Captured with the Clarity RetCam 3 (130° field of view); pediatric wide-field fundus photograph — 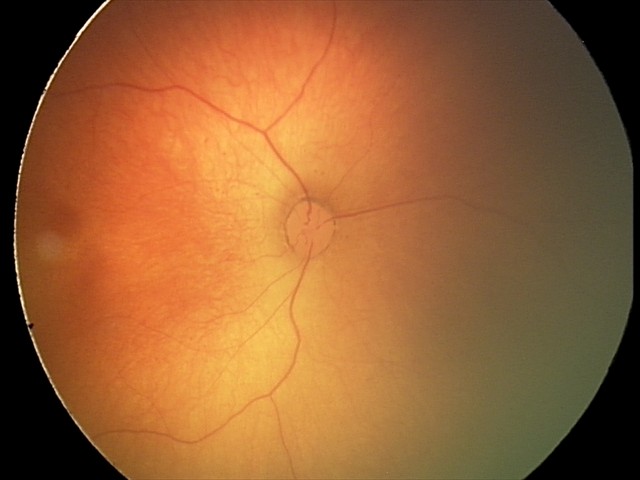
Diagnosis: physiological appearance.